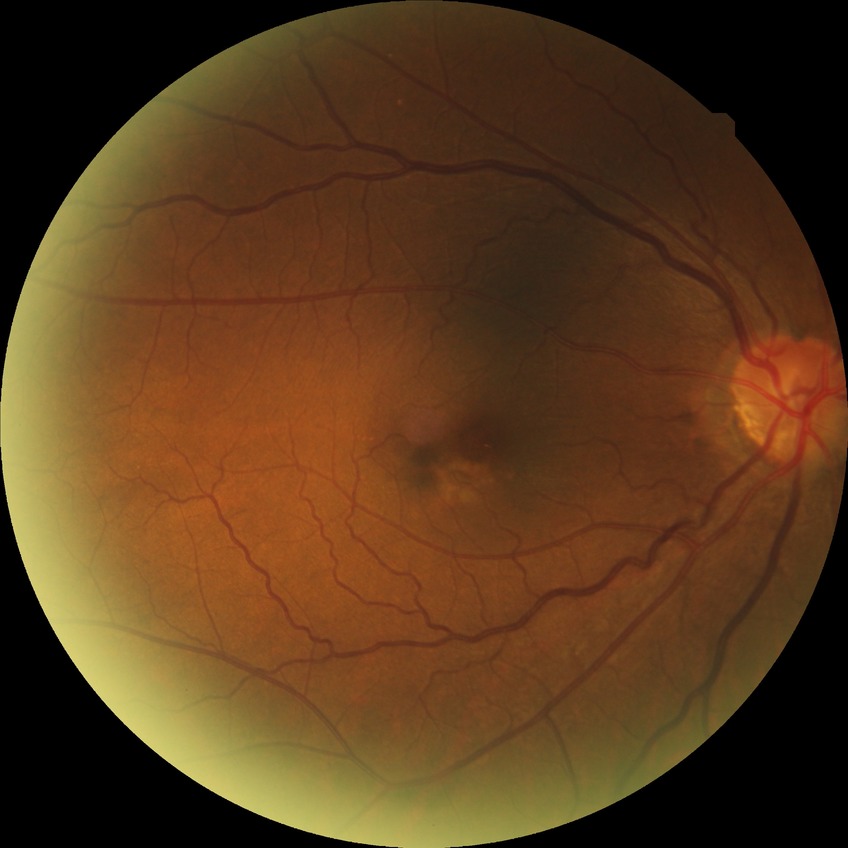

Retinopathy grade is no diabetic retinopathy.